Female patient; intraocular pressure 18 mmHg:
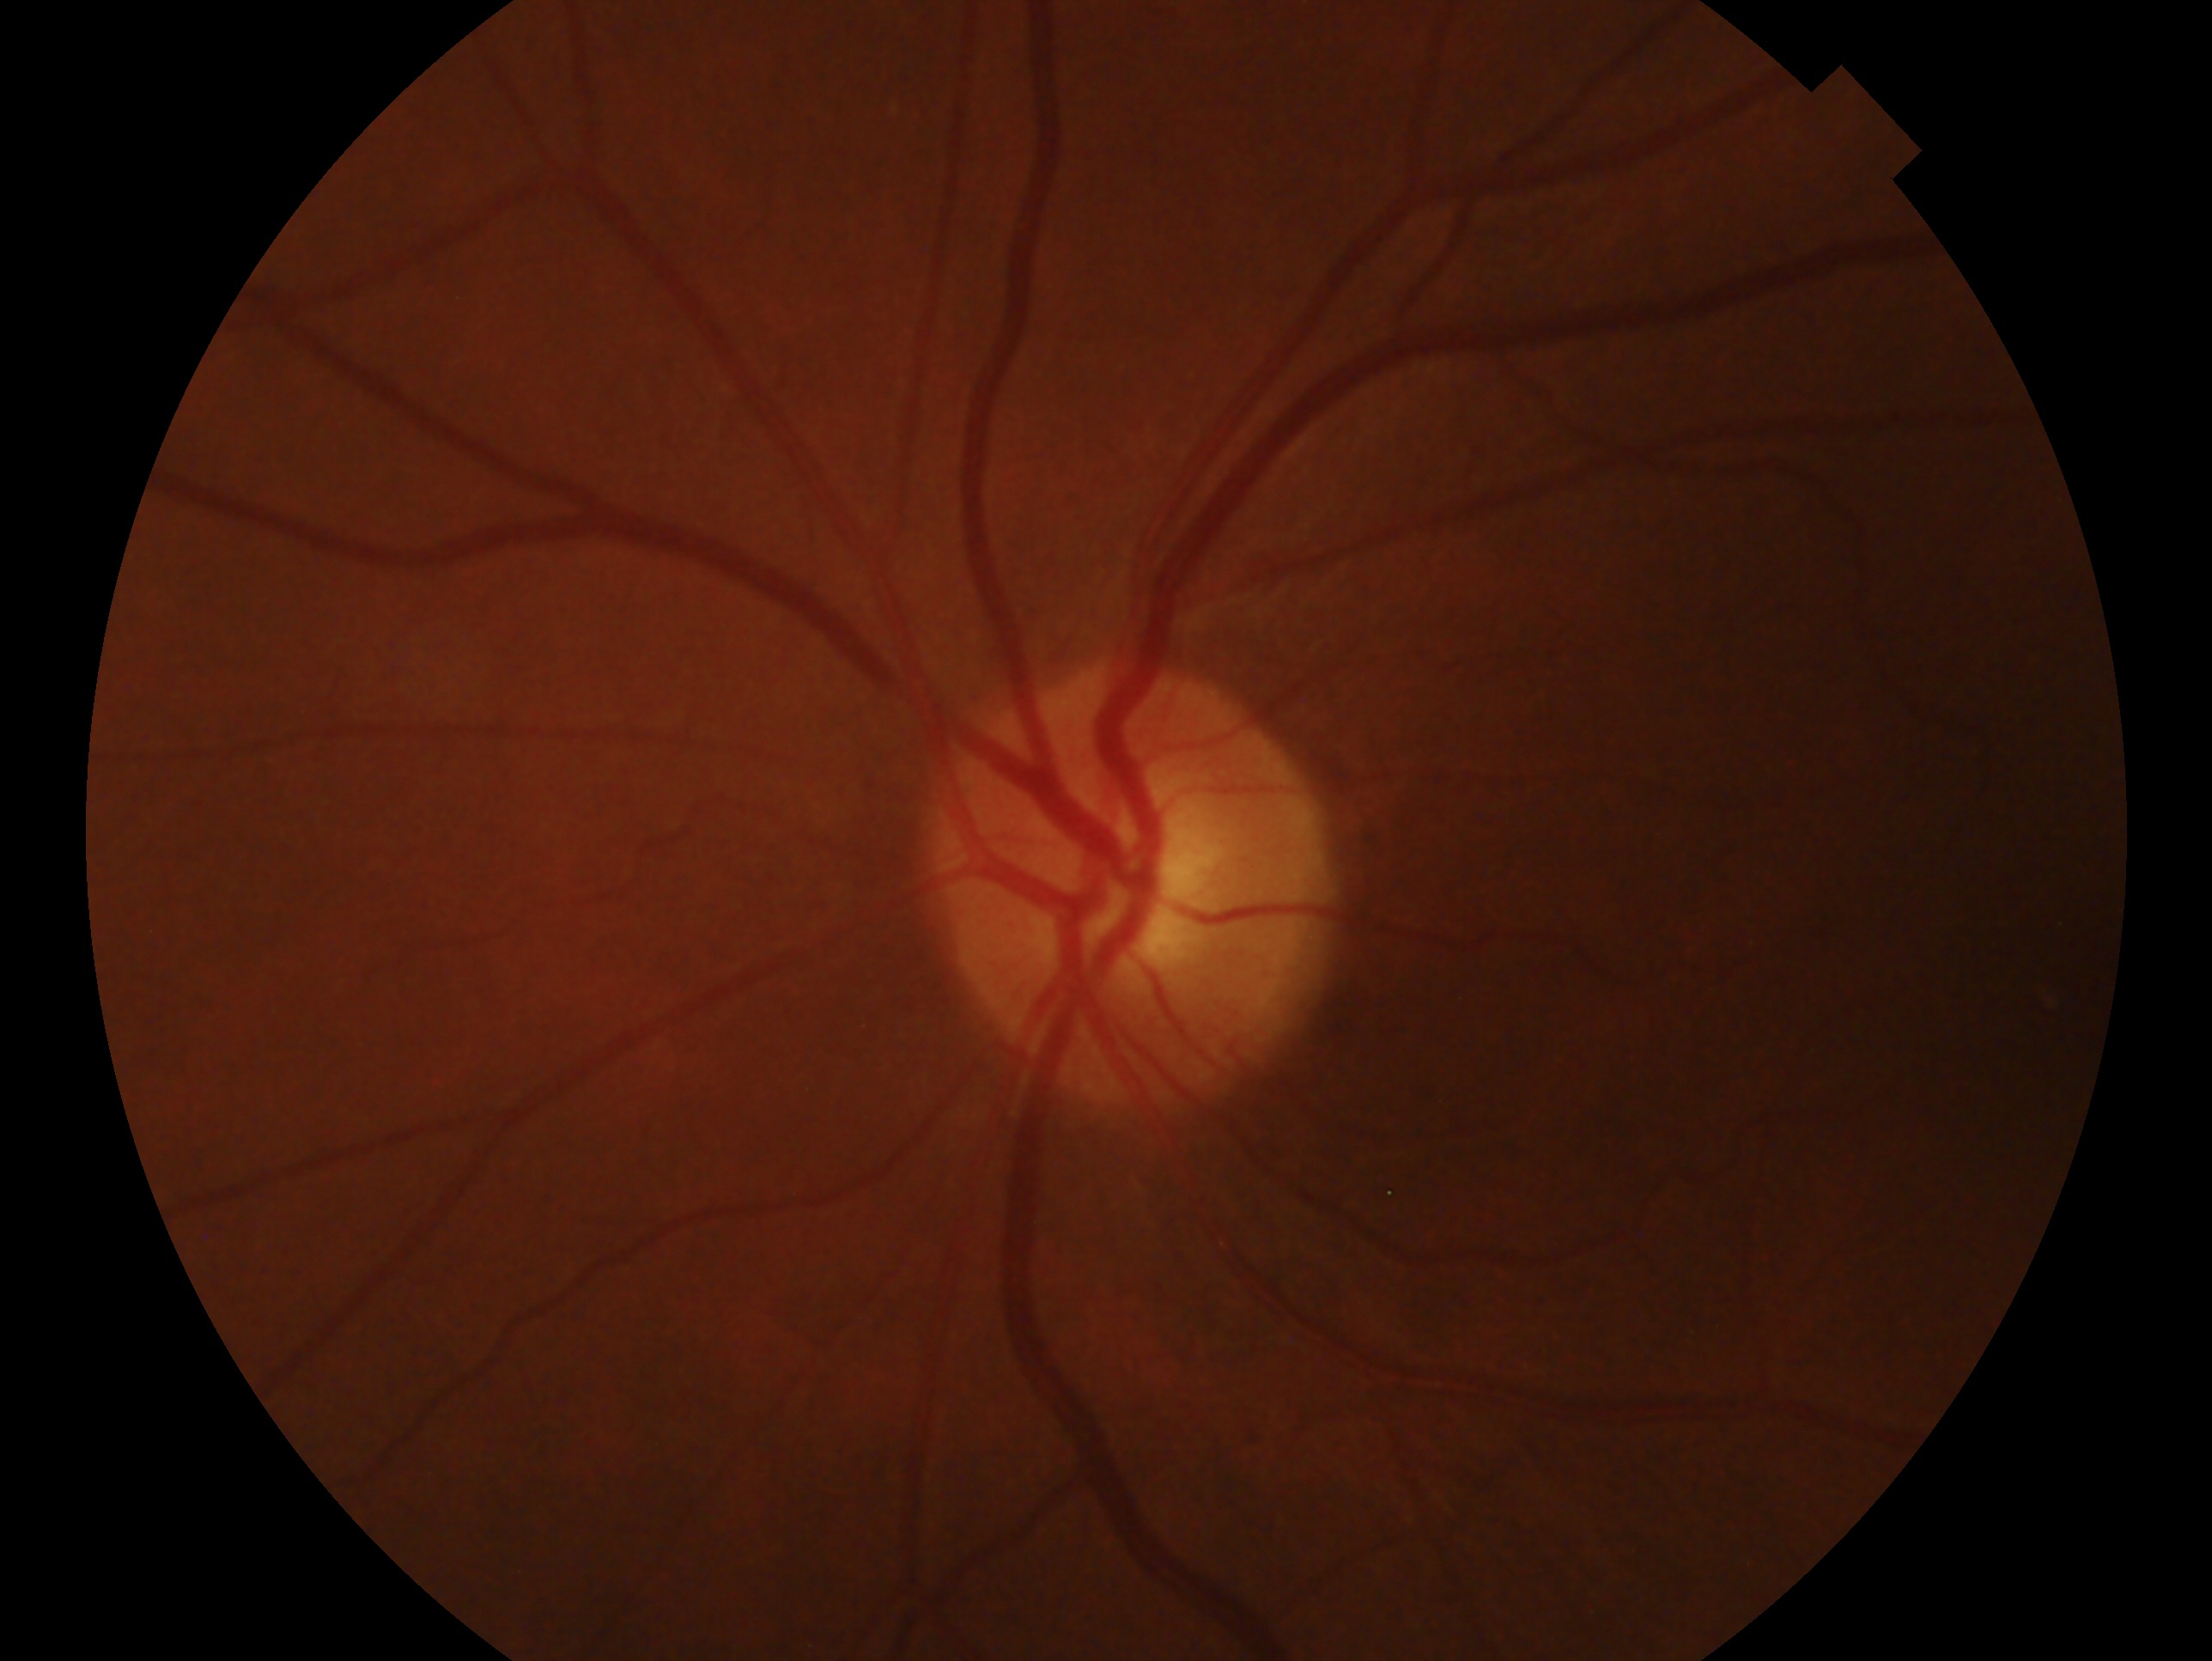 laterality: left eye | impression: negative for glaucoma.